2048x1536px:
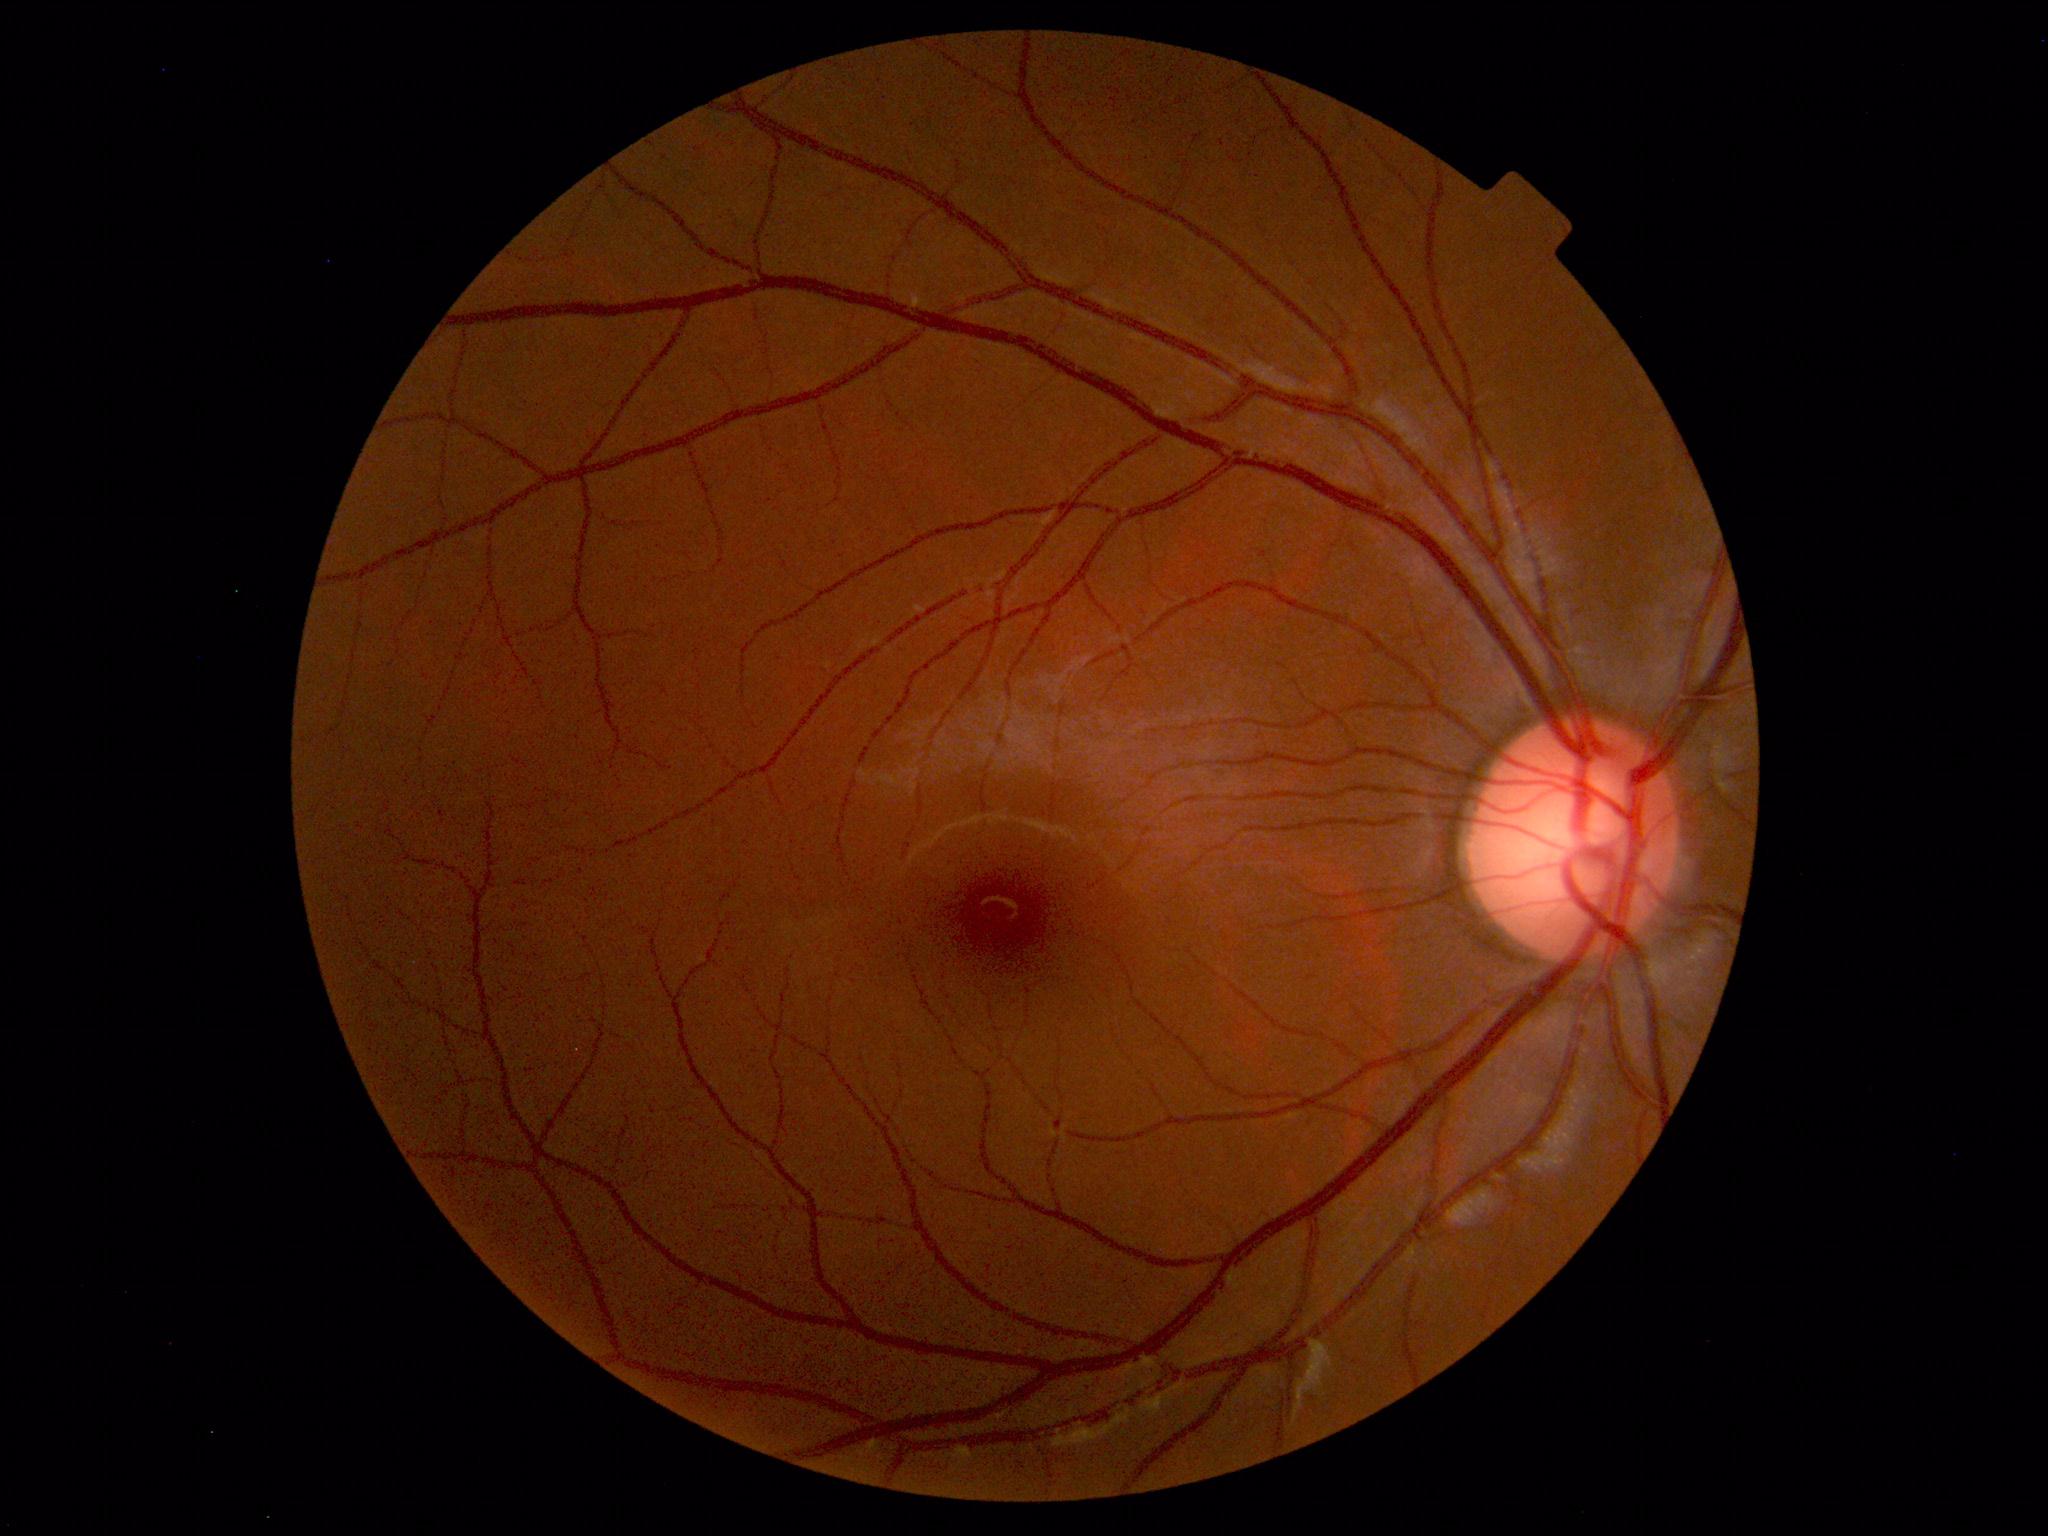

Normal fundus. No pathology identified.